512x512px.
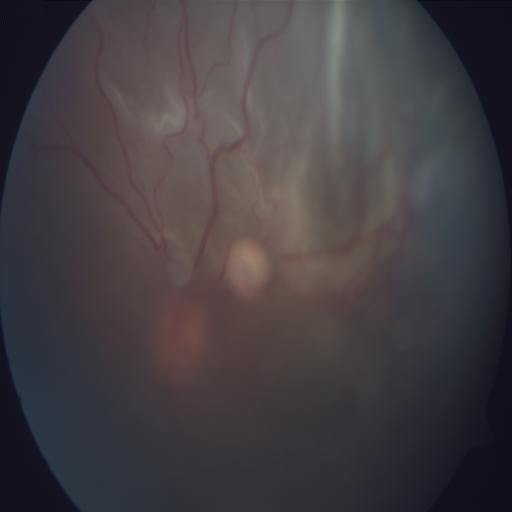
Fundus image with findings of retinal detachment (RD).